Without pupil dilation; camera: NIDEK AFC-230: 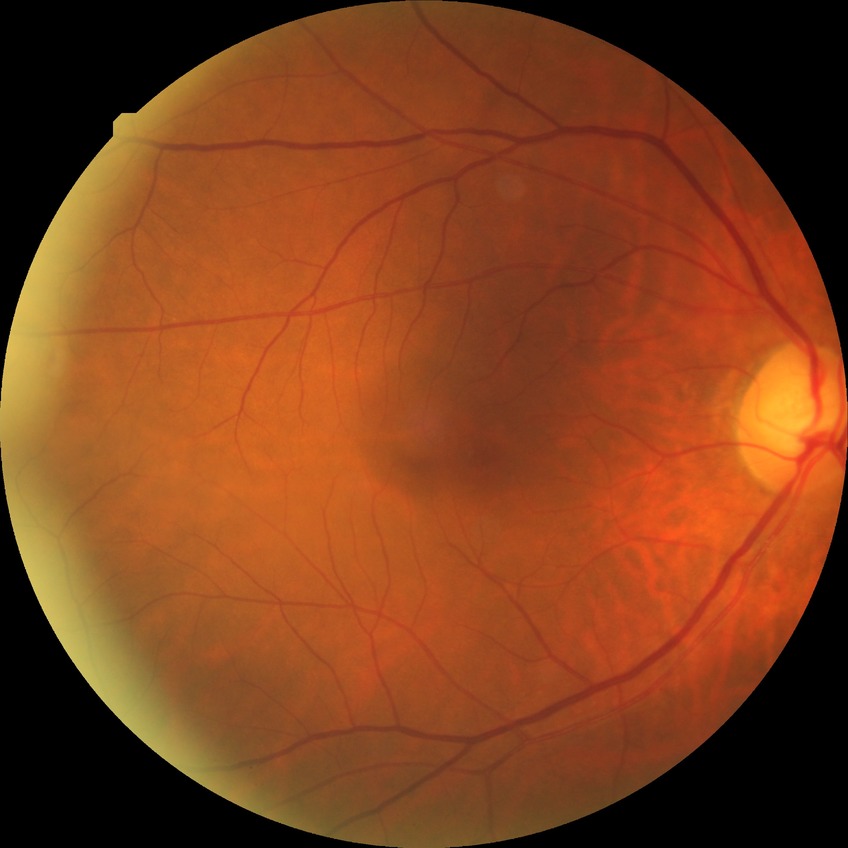

Diabetic retinopathy (DR): no diabetic retinopathy (NDR).